100° field of view (Phoenix ICON); infant wide-field retinal image; 1240x1240px — 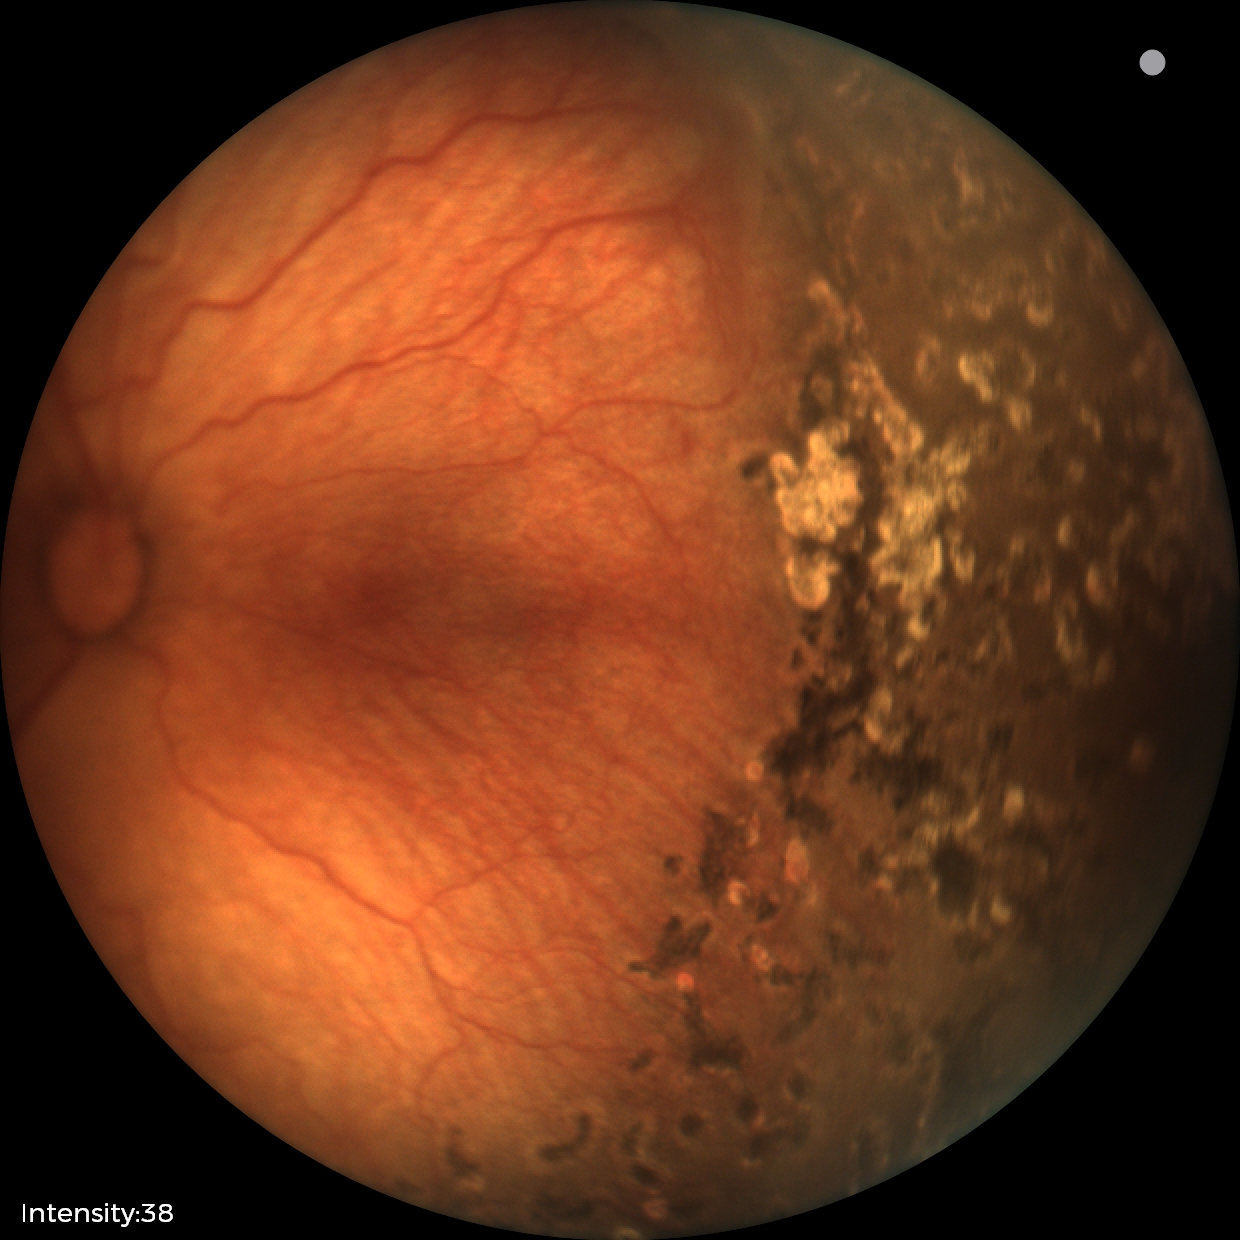
Finding: status post retinopathy of prematurity (ROP), plus disease: absent — posterior pole vessels without abnormal dilation or tortuosity.